2352x1568 — 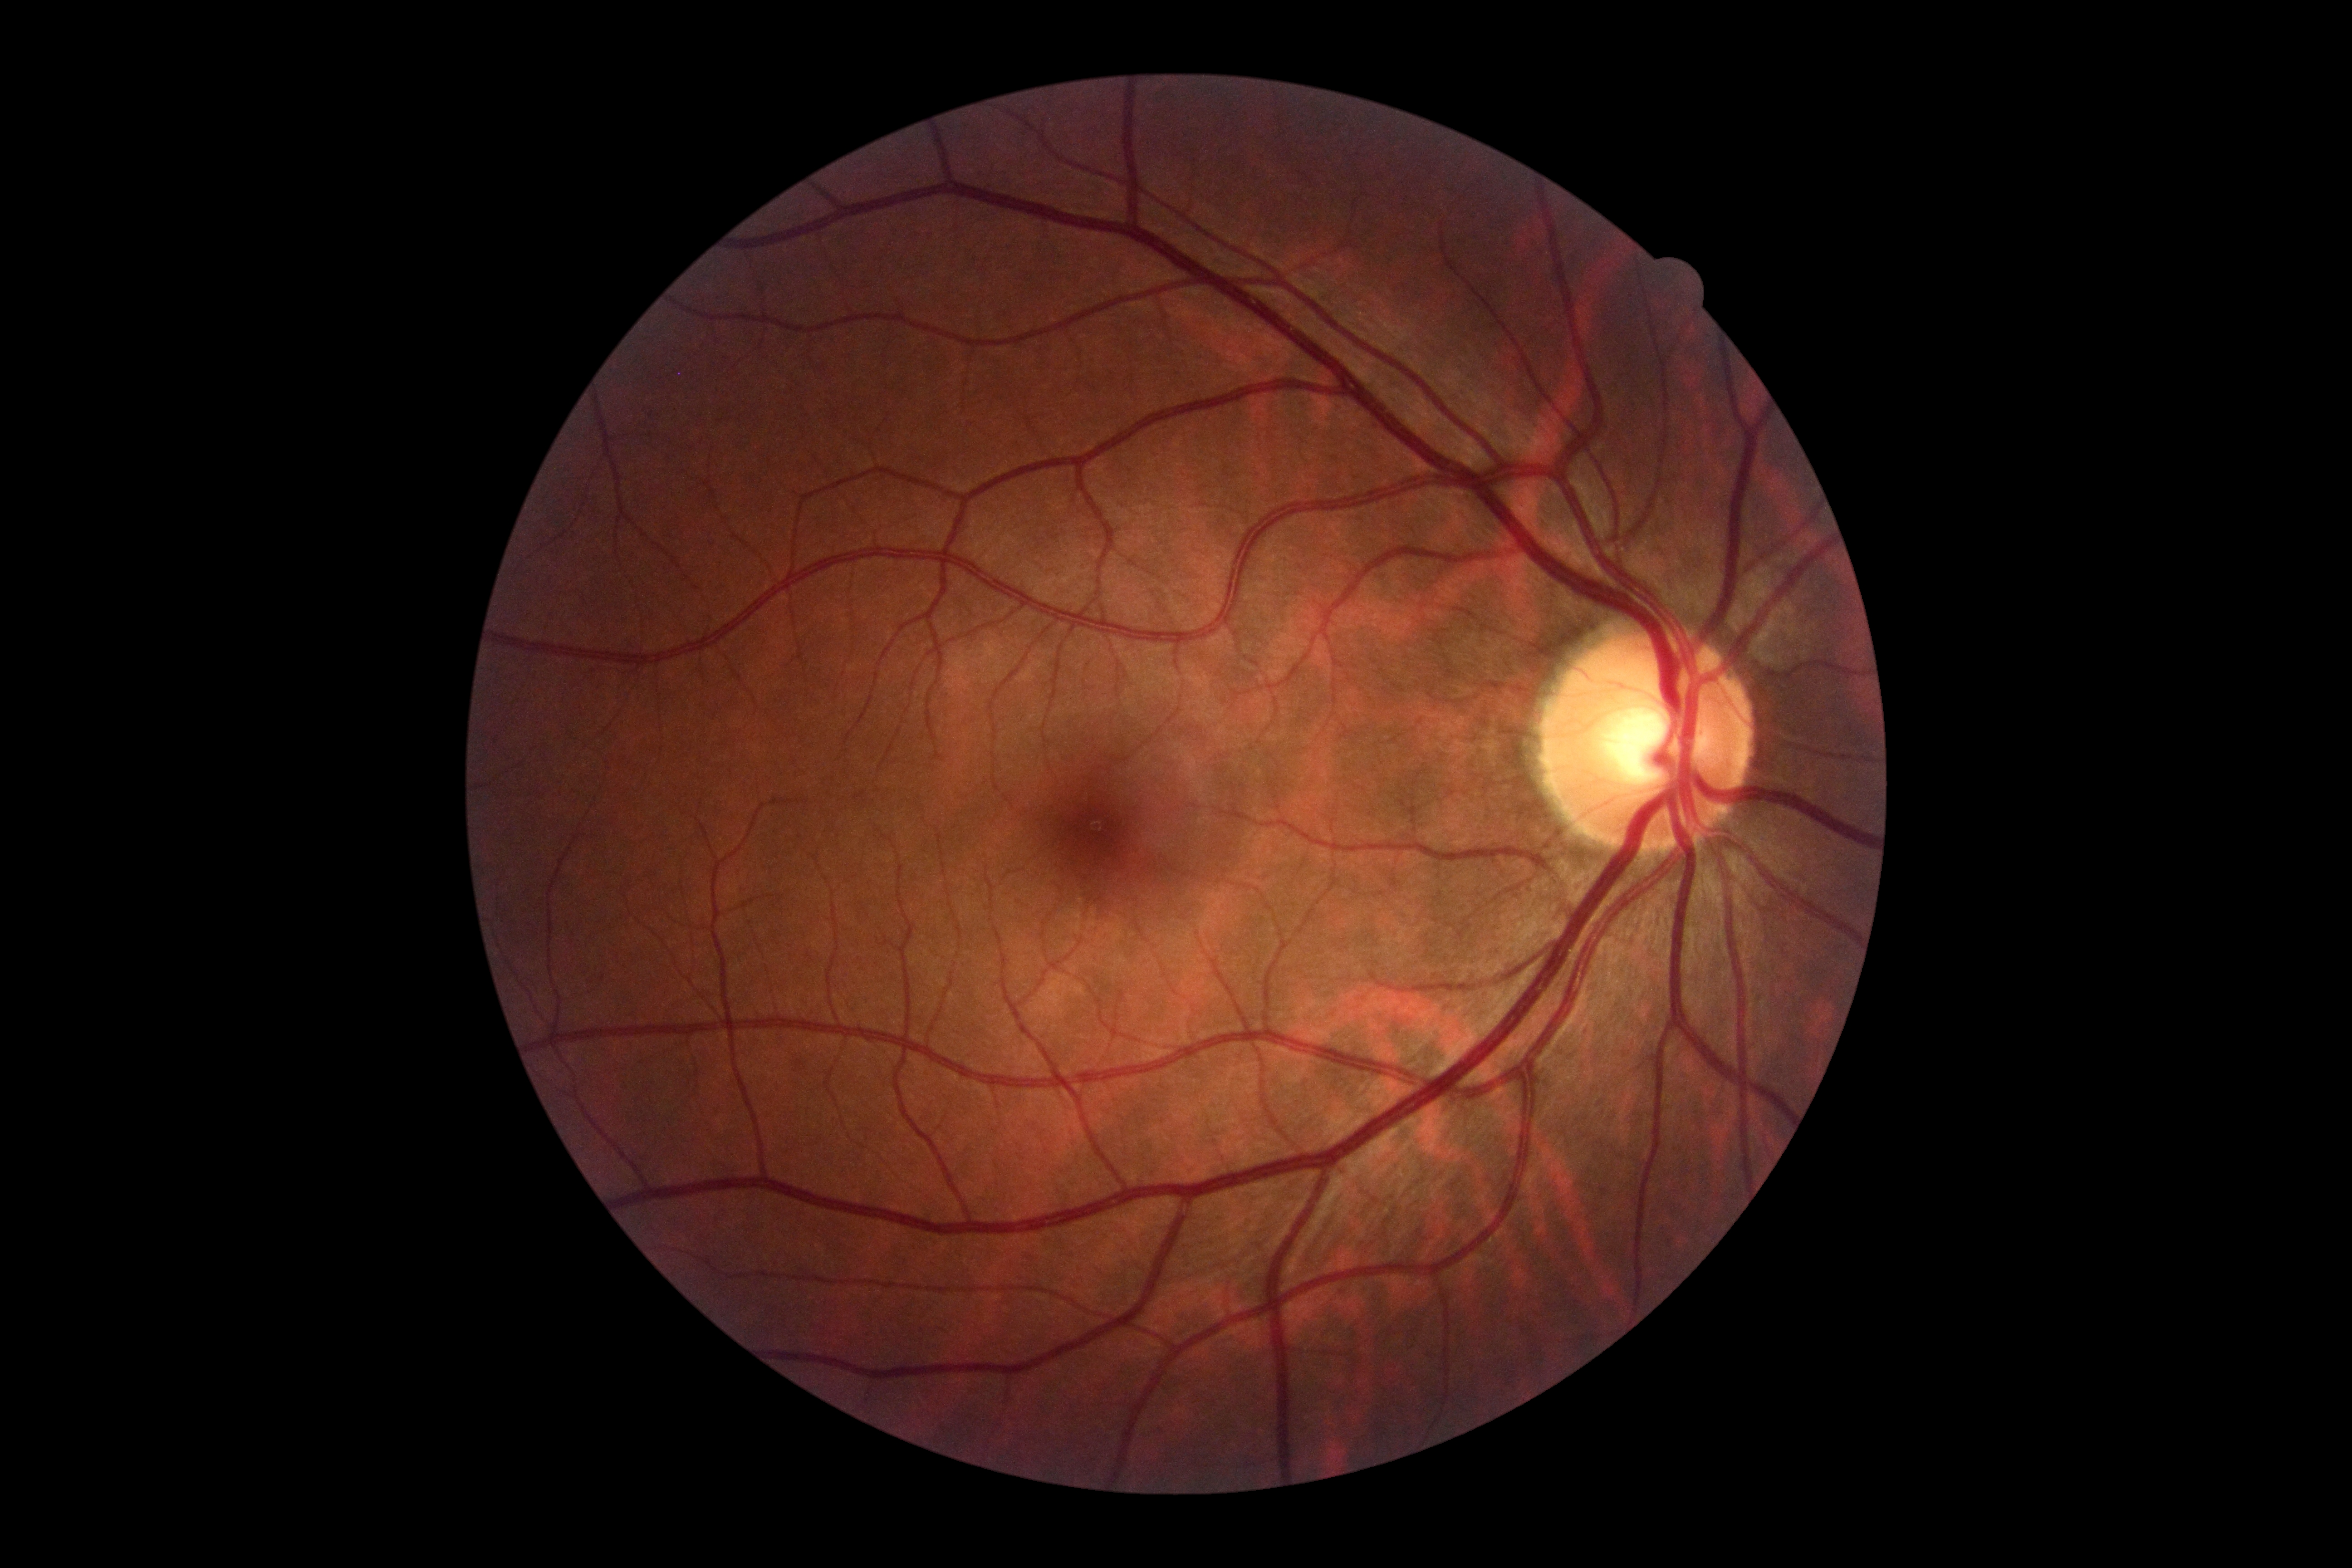 DR severity: no apparent diabetic retinopathy (grade 0).